Wide-field fundus photograph from neonatal ROP screening; captured with the Clarity RetCam 3 (130° field of view).
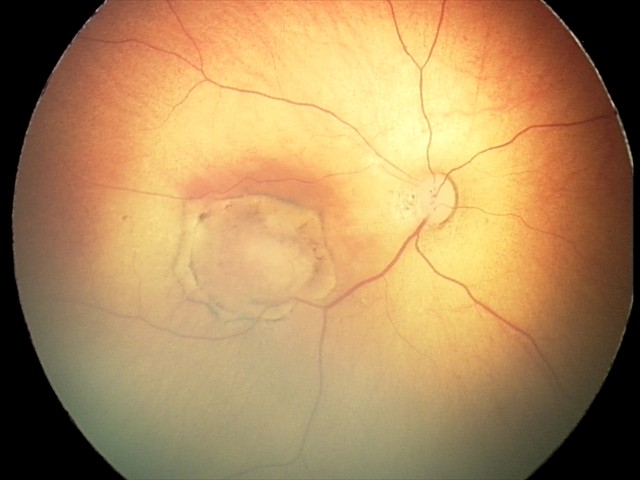

Screening diagnosis = toxoplasmosis chorioretinitis.